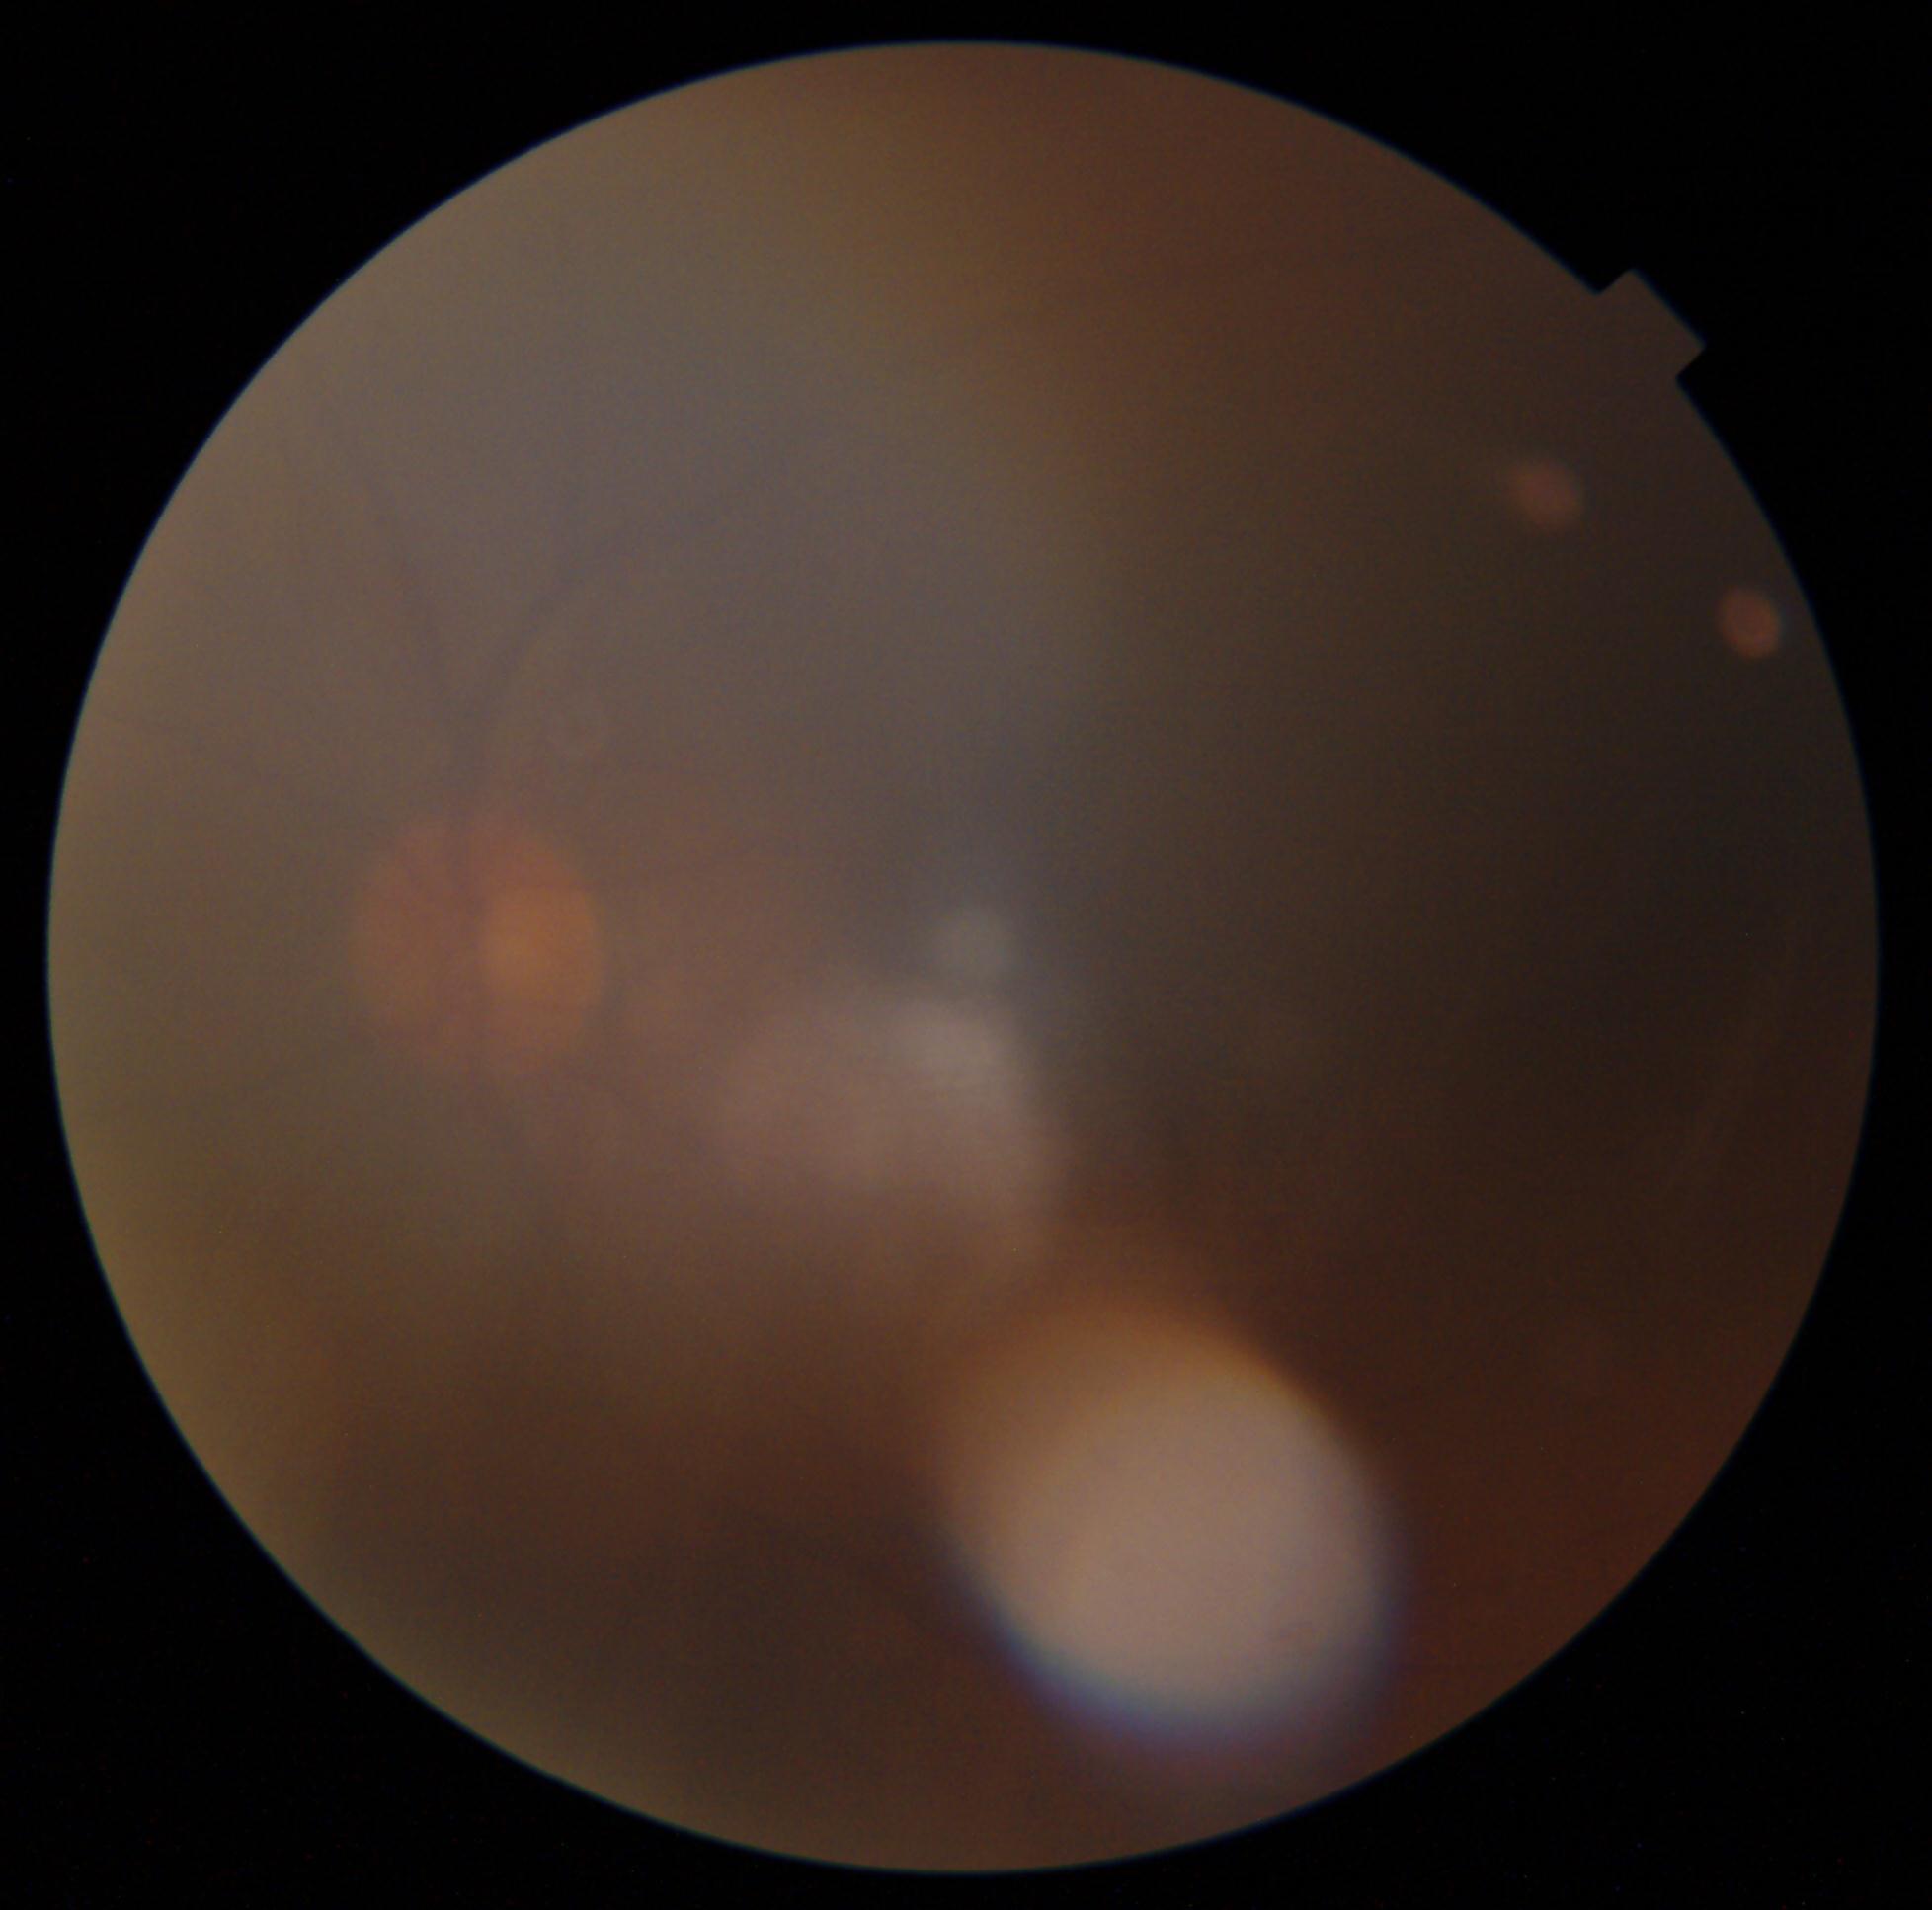 – retinopathy — ungradable
– image quality — too poor for DR grading